640x480px; infant wide-field fundus photograph:
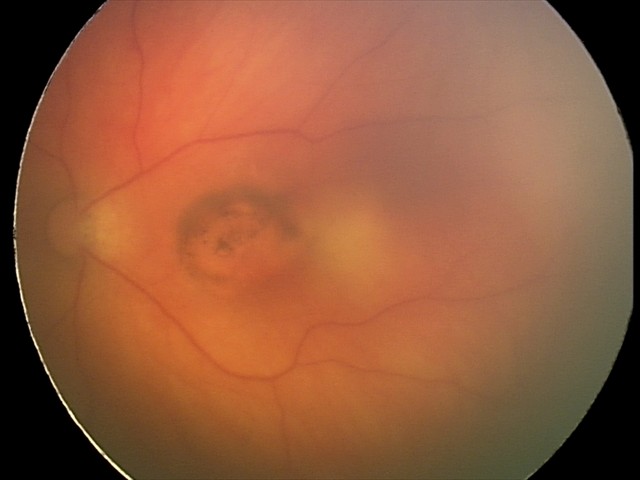

Q: What is the diagnosis from this examination?
A: toxoplasmosis chorioretinitis